Fundus image cropped to the optic disc: 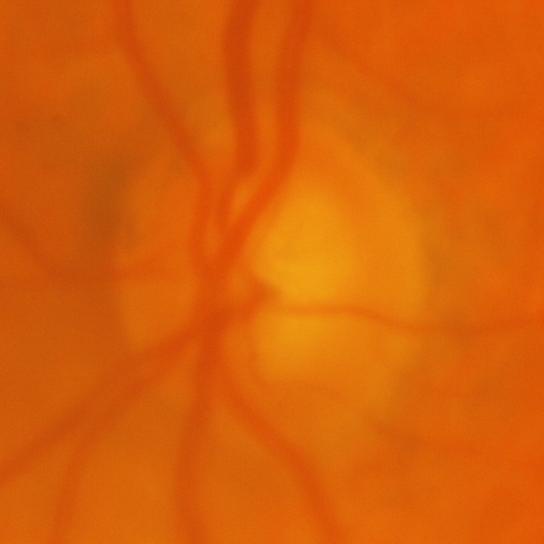
Showing evidence of glaucoma.